Color fundus image · 45-degree field of view
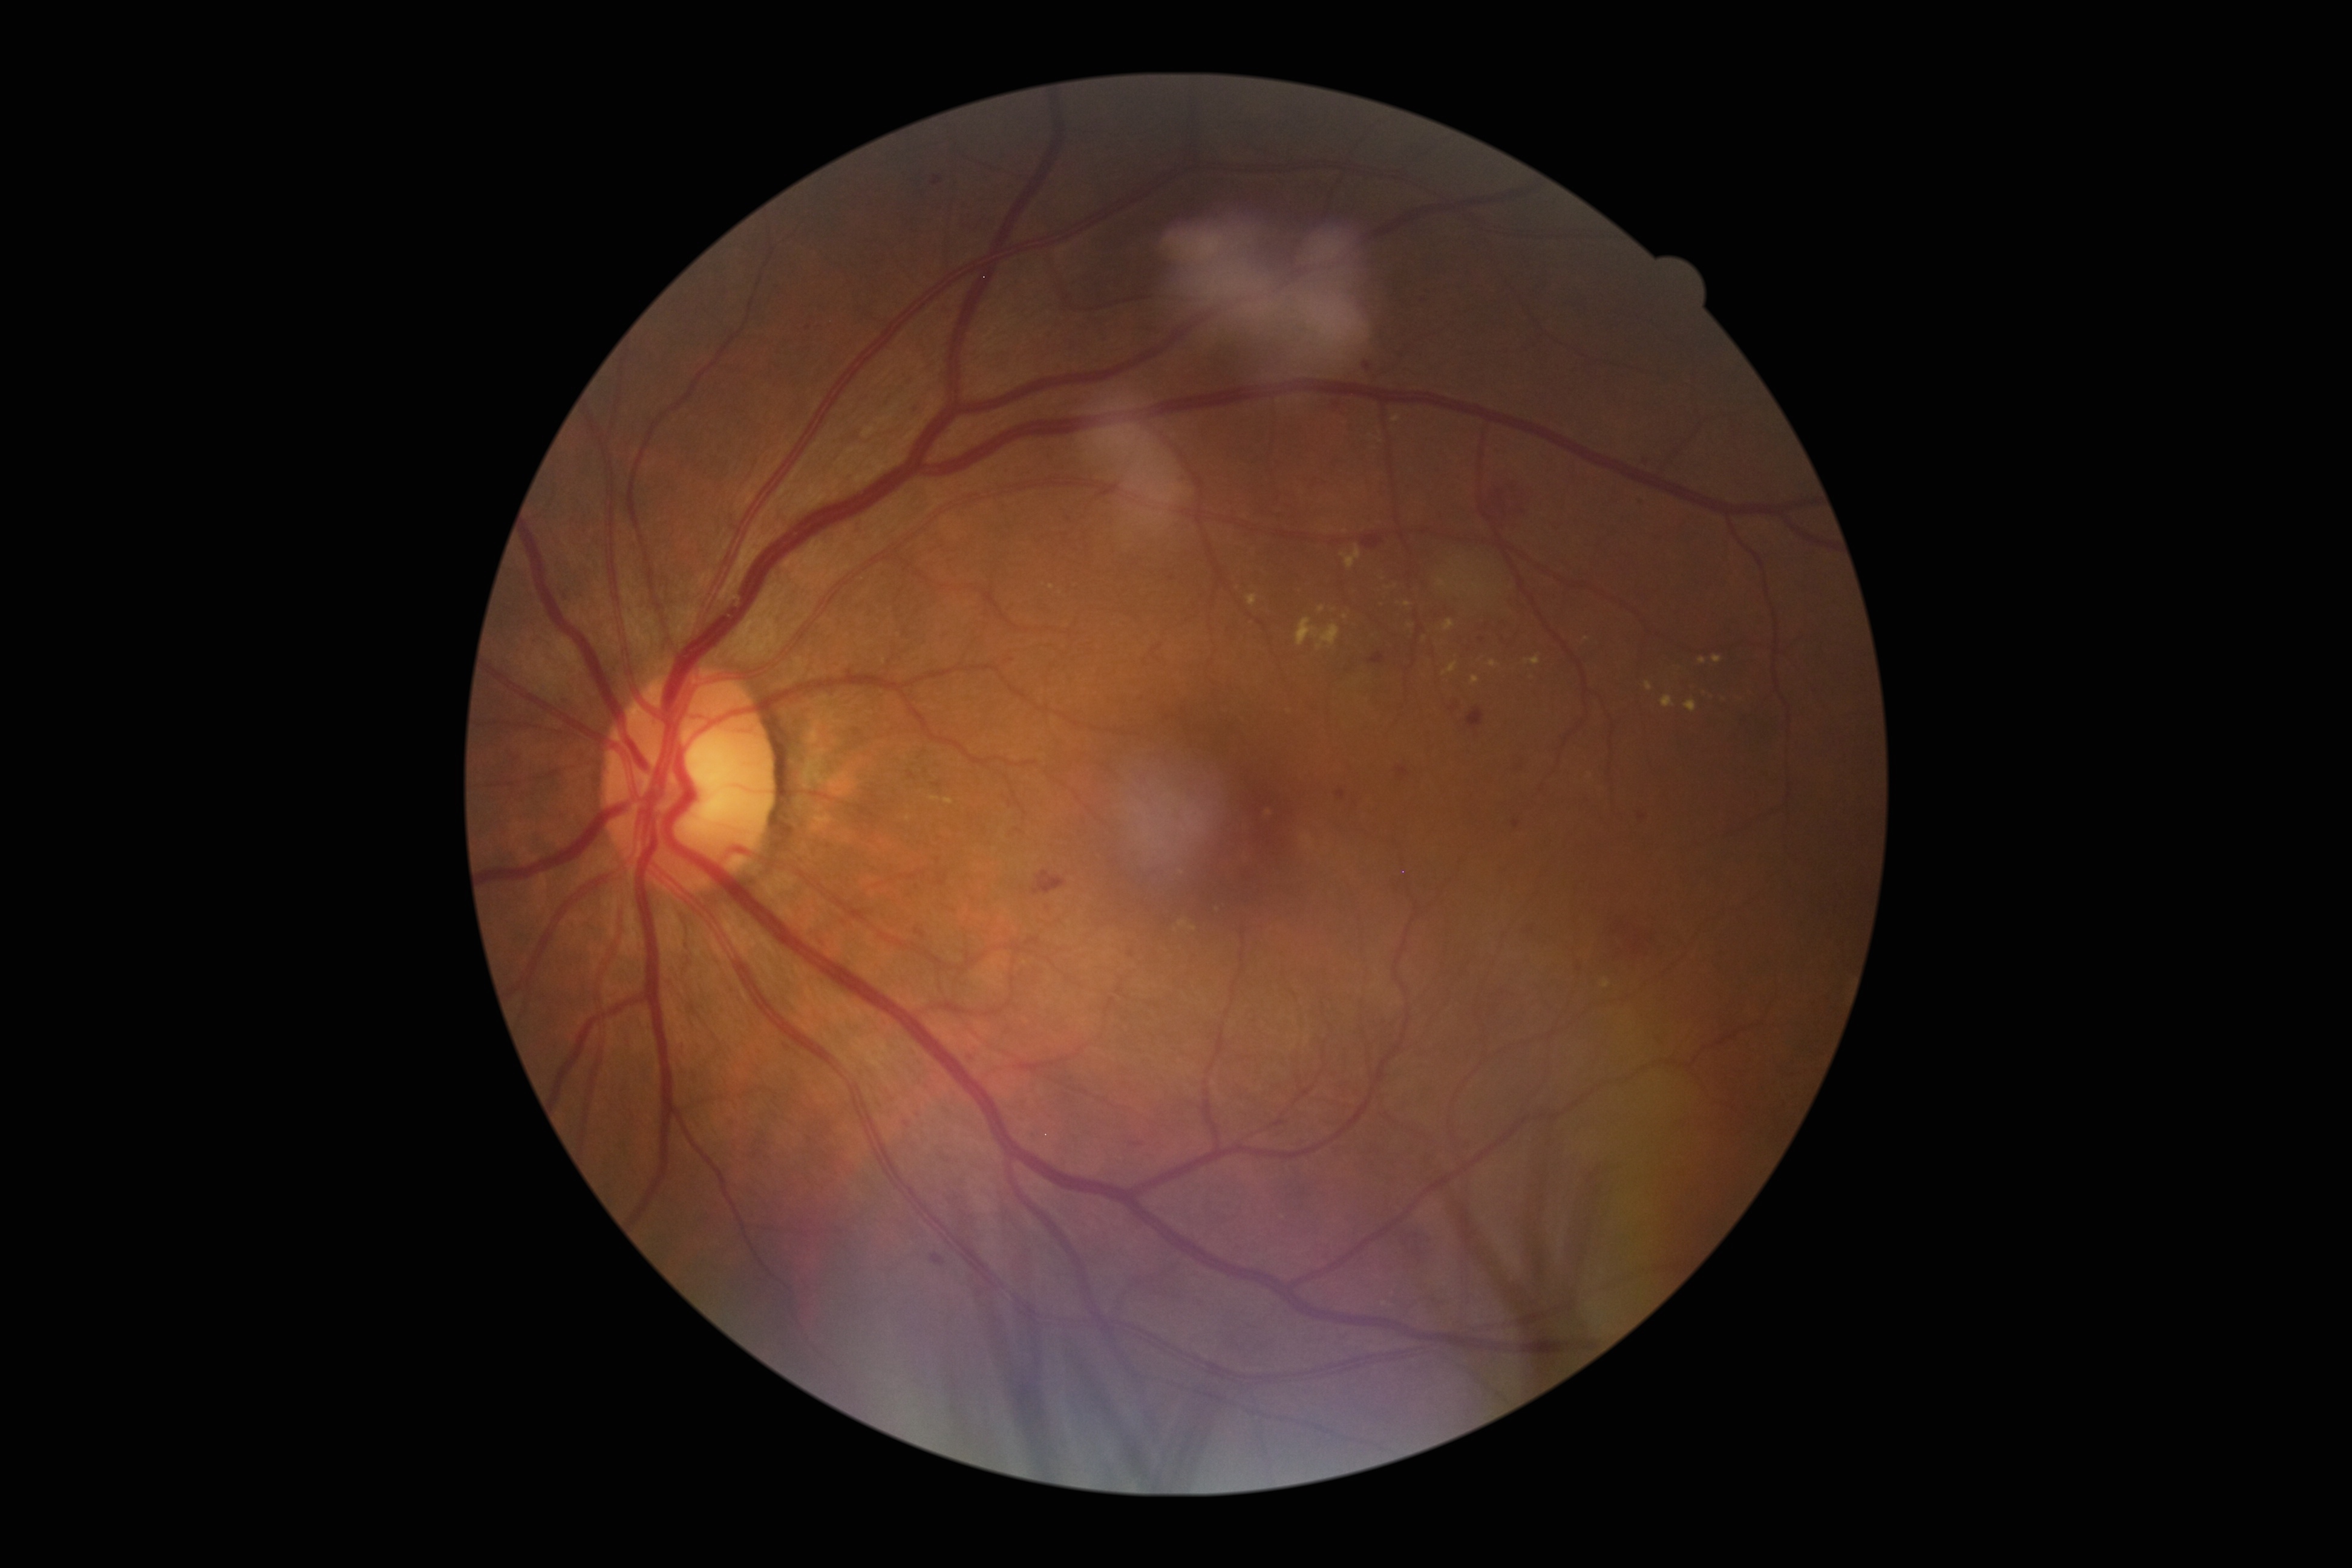 {"partial": true, "dr_grade": 2, "lesions": {"he": [[1467, 706, 1485, 729], [1450, 705, 1459, 712], [1400, 1227, 1434, 1269], [1368, 653, 1385, 665], [906, 400, 925, 418], [915, 927, 926, 939], [1633, 495, 1650, 512], [1578, 918, 1673, 987], [932, 176, 942, 186], [720, 1114, 742, 1132], [1513, 820, 1520, 829], [1504, 752, 1535, 779], [961, 1051, 978, 1065]], "he_small": [[1171, 579], [808, 328], [1131, 955], [1642, 817]], "ma": null, "ex": [[1685, 699, 1697, 712], [1489, 660, 1498, 667], [1295, 618, 1340, 649], [1645, 682, 1653, 691], [1443, 619, 1456, 631], [1406, 625, 1414, 629], [1524, 656, 1541, 665], [1442, 662, 1457, 676], [931, 795, 941, 802], [1713, 655, 1723, 664], [1179, 921, 1189, 927]], "ex_small": [[1464, 576], [1452, 582], [1465, 588], [1193, 928], [1591, 775]], "se": null}}